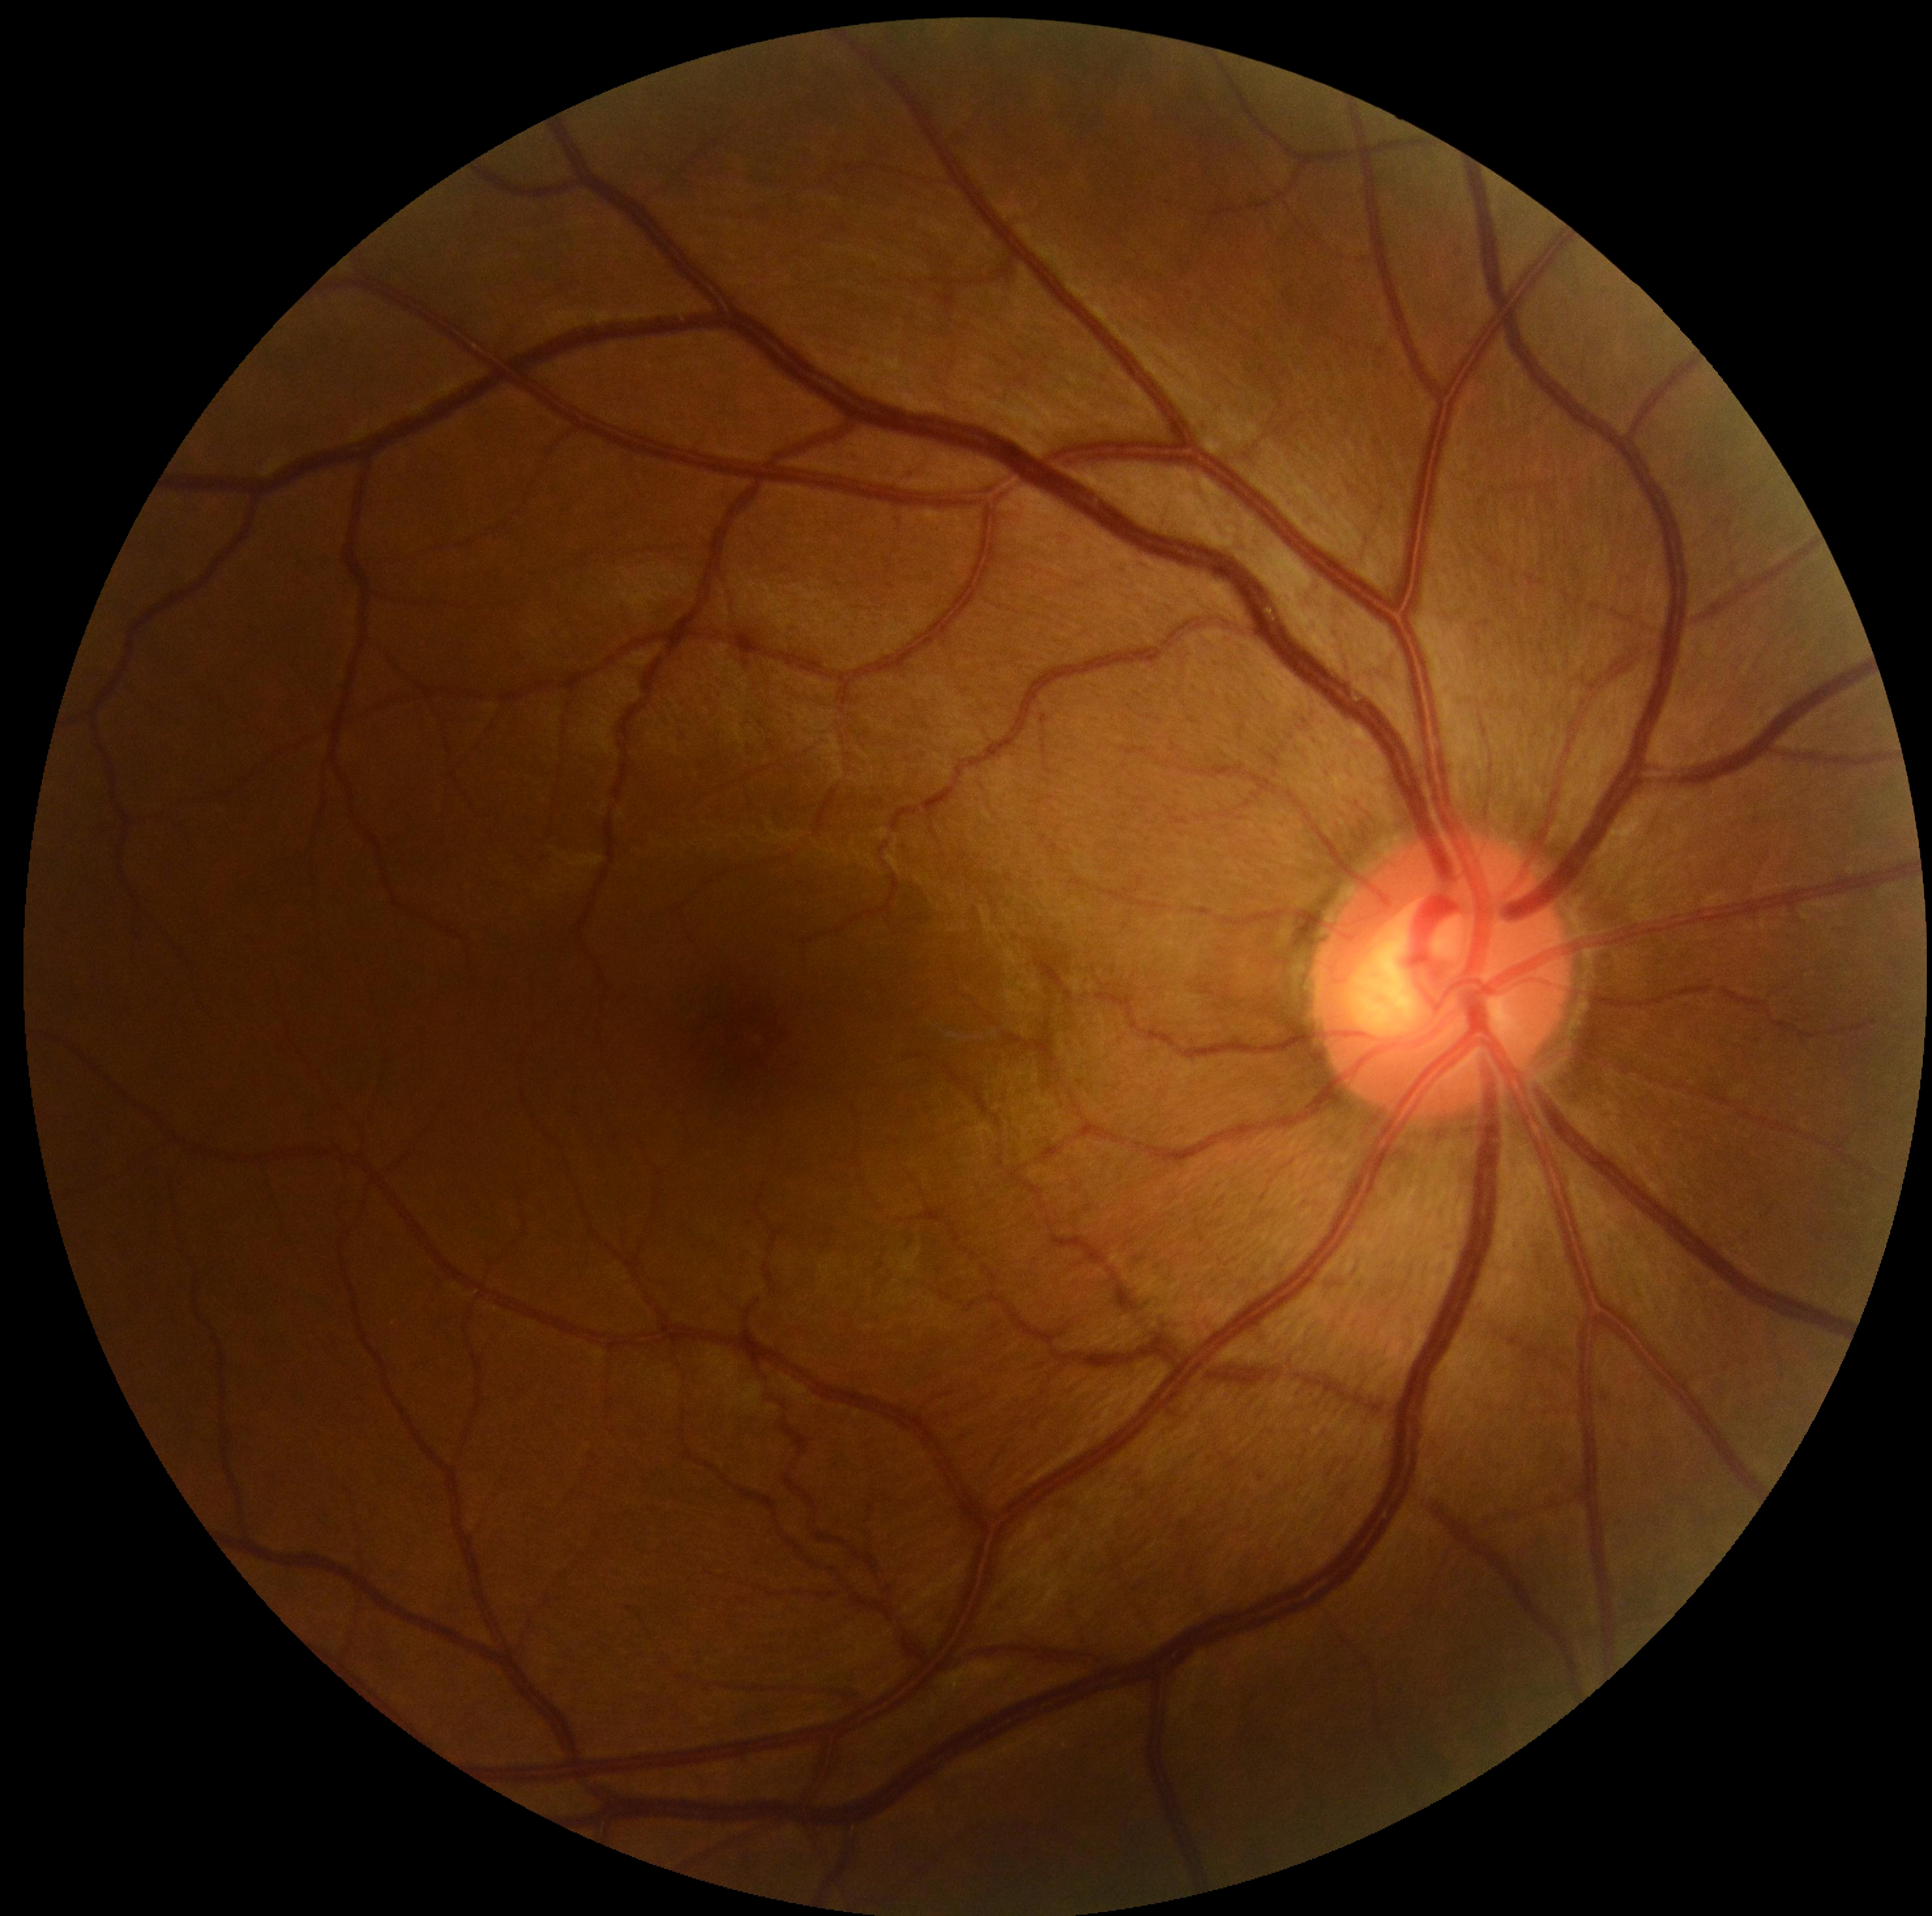 No signs of diabetic retinopathy. Retinopathy is 0/4 — no visible signs of diabetic retinopathy.